CFP: 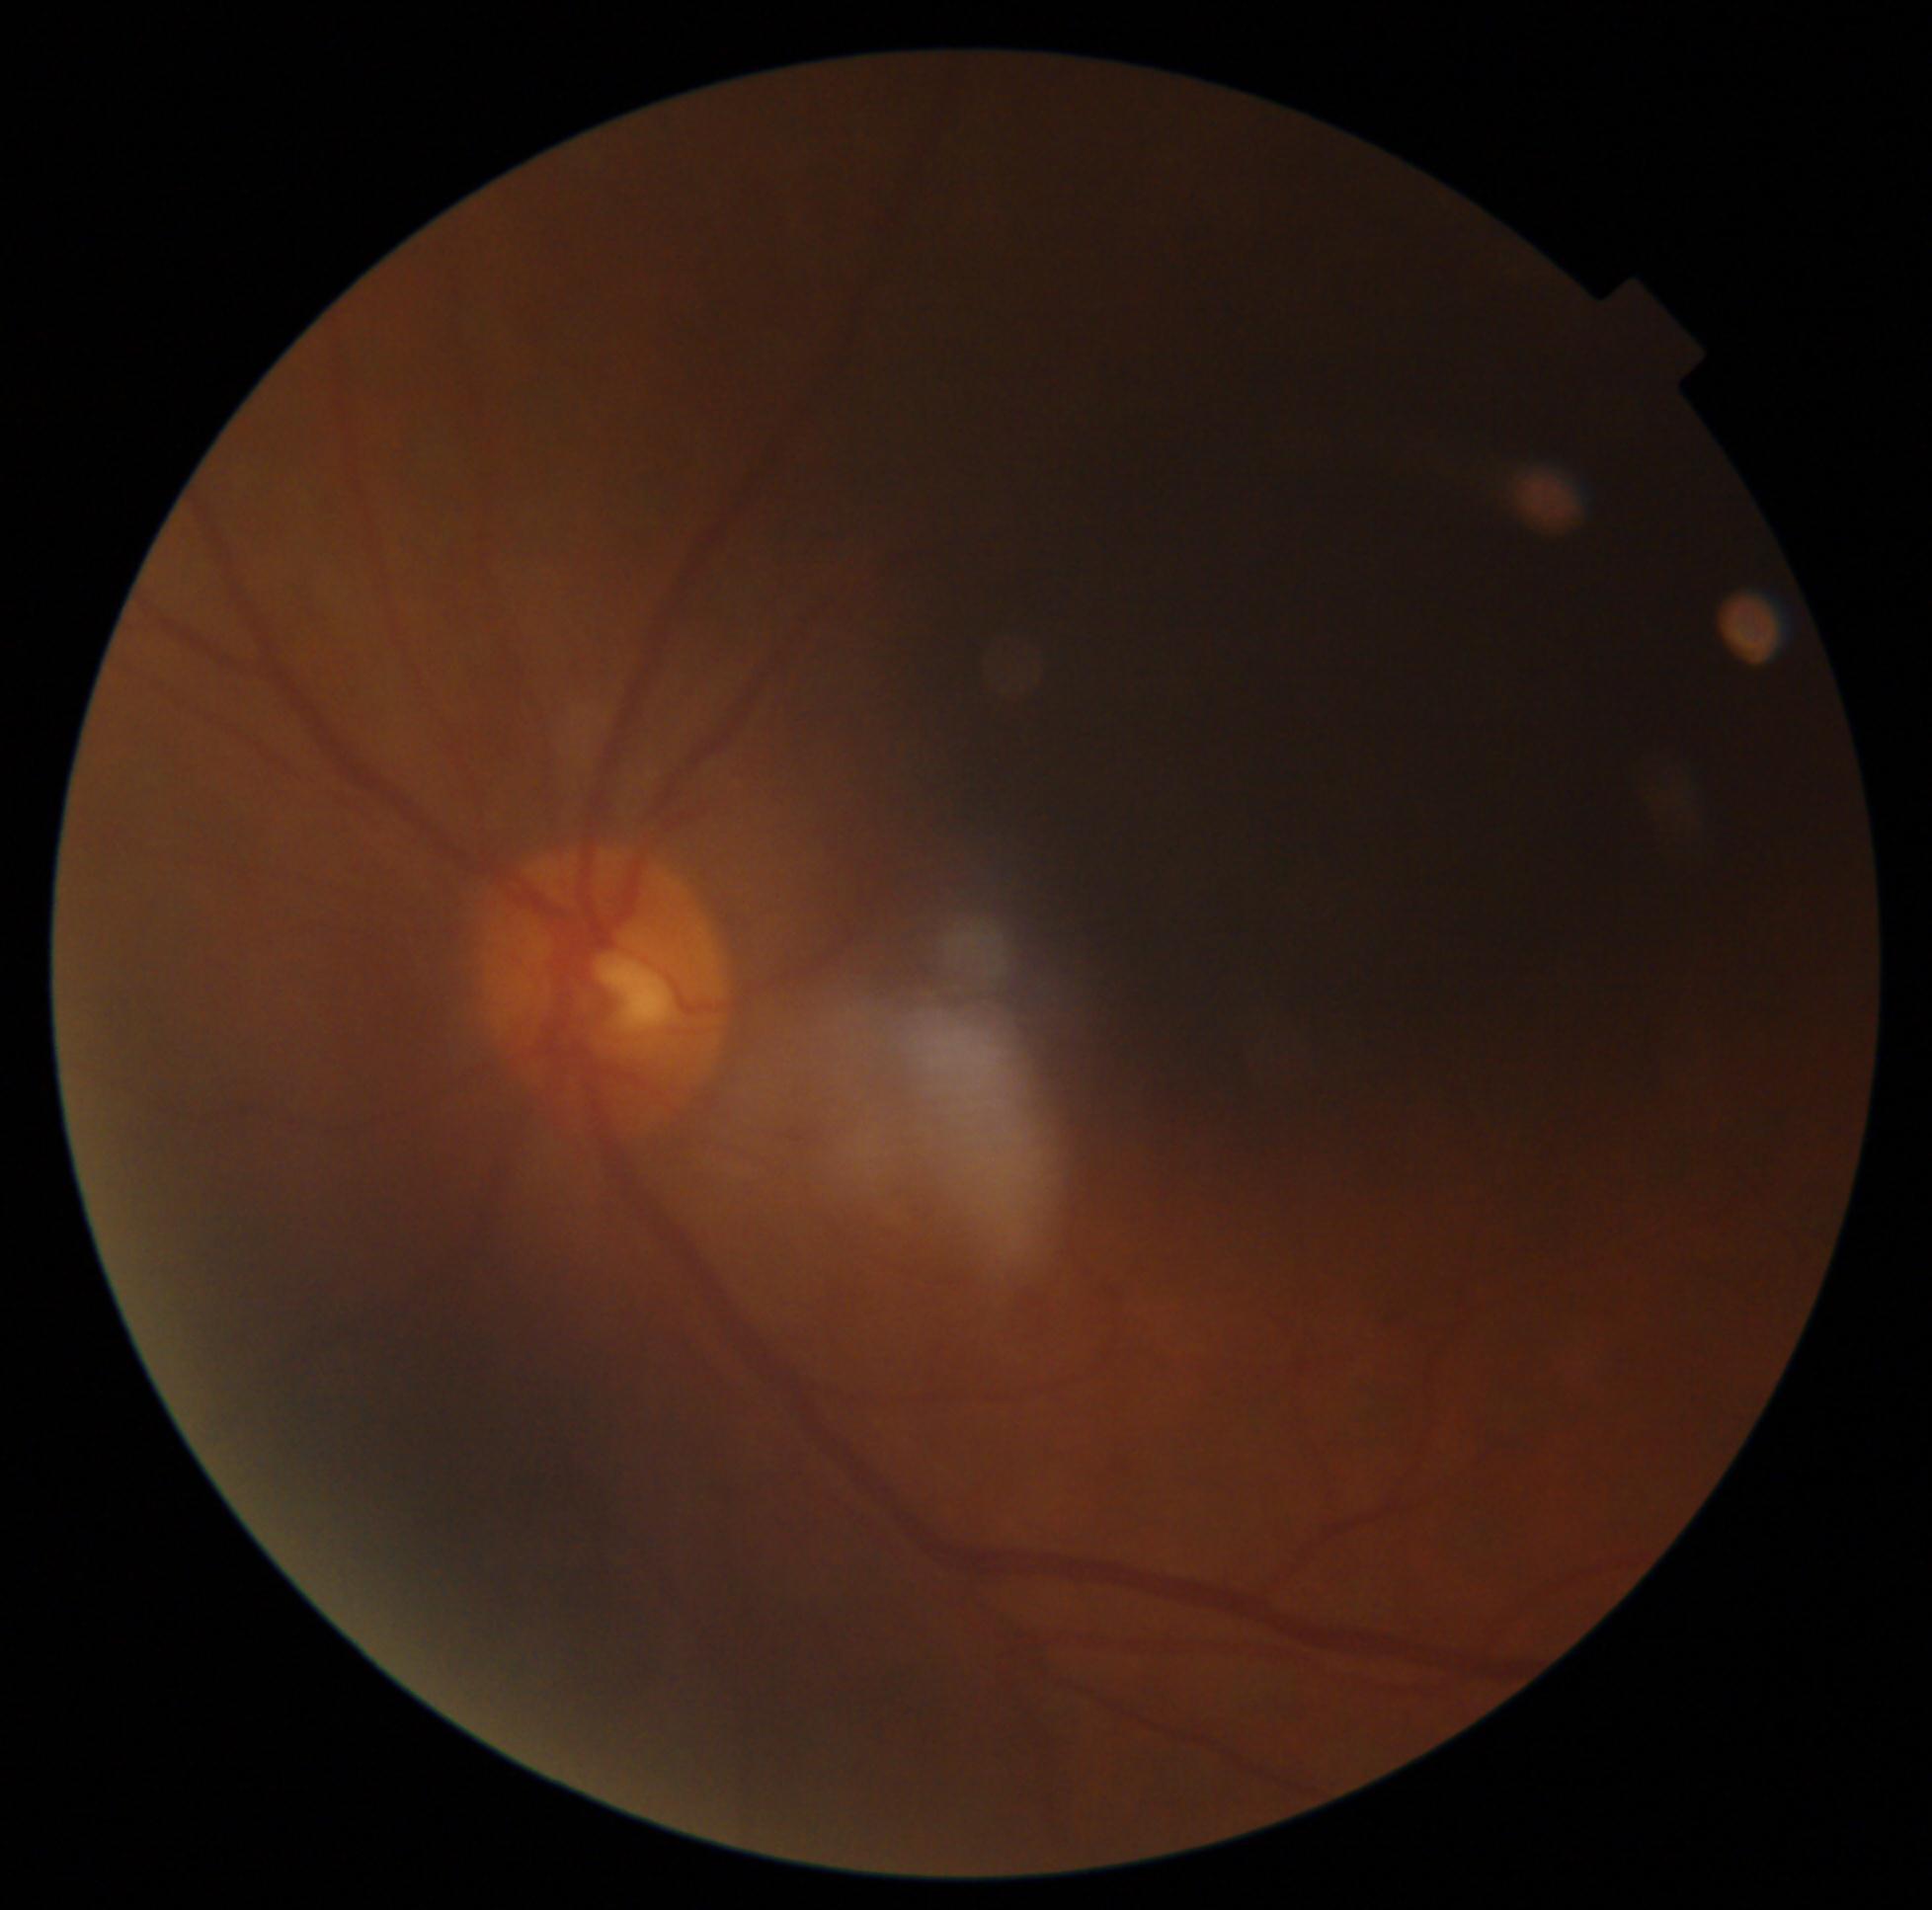 DR stage: ungradable.